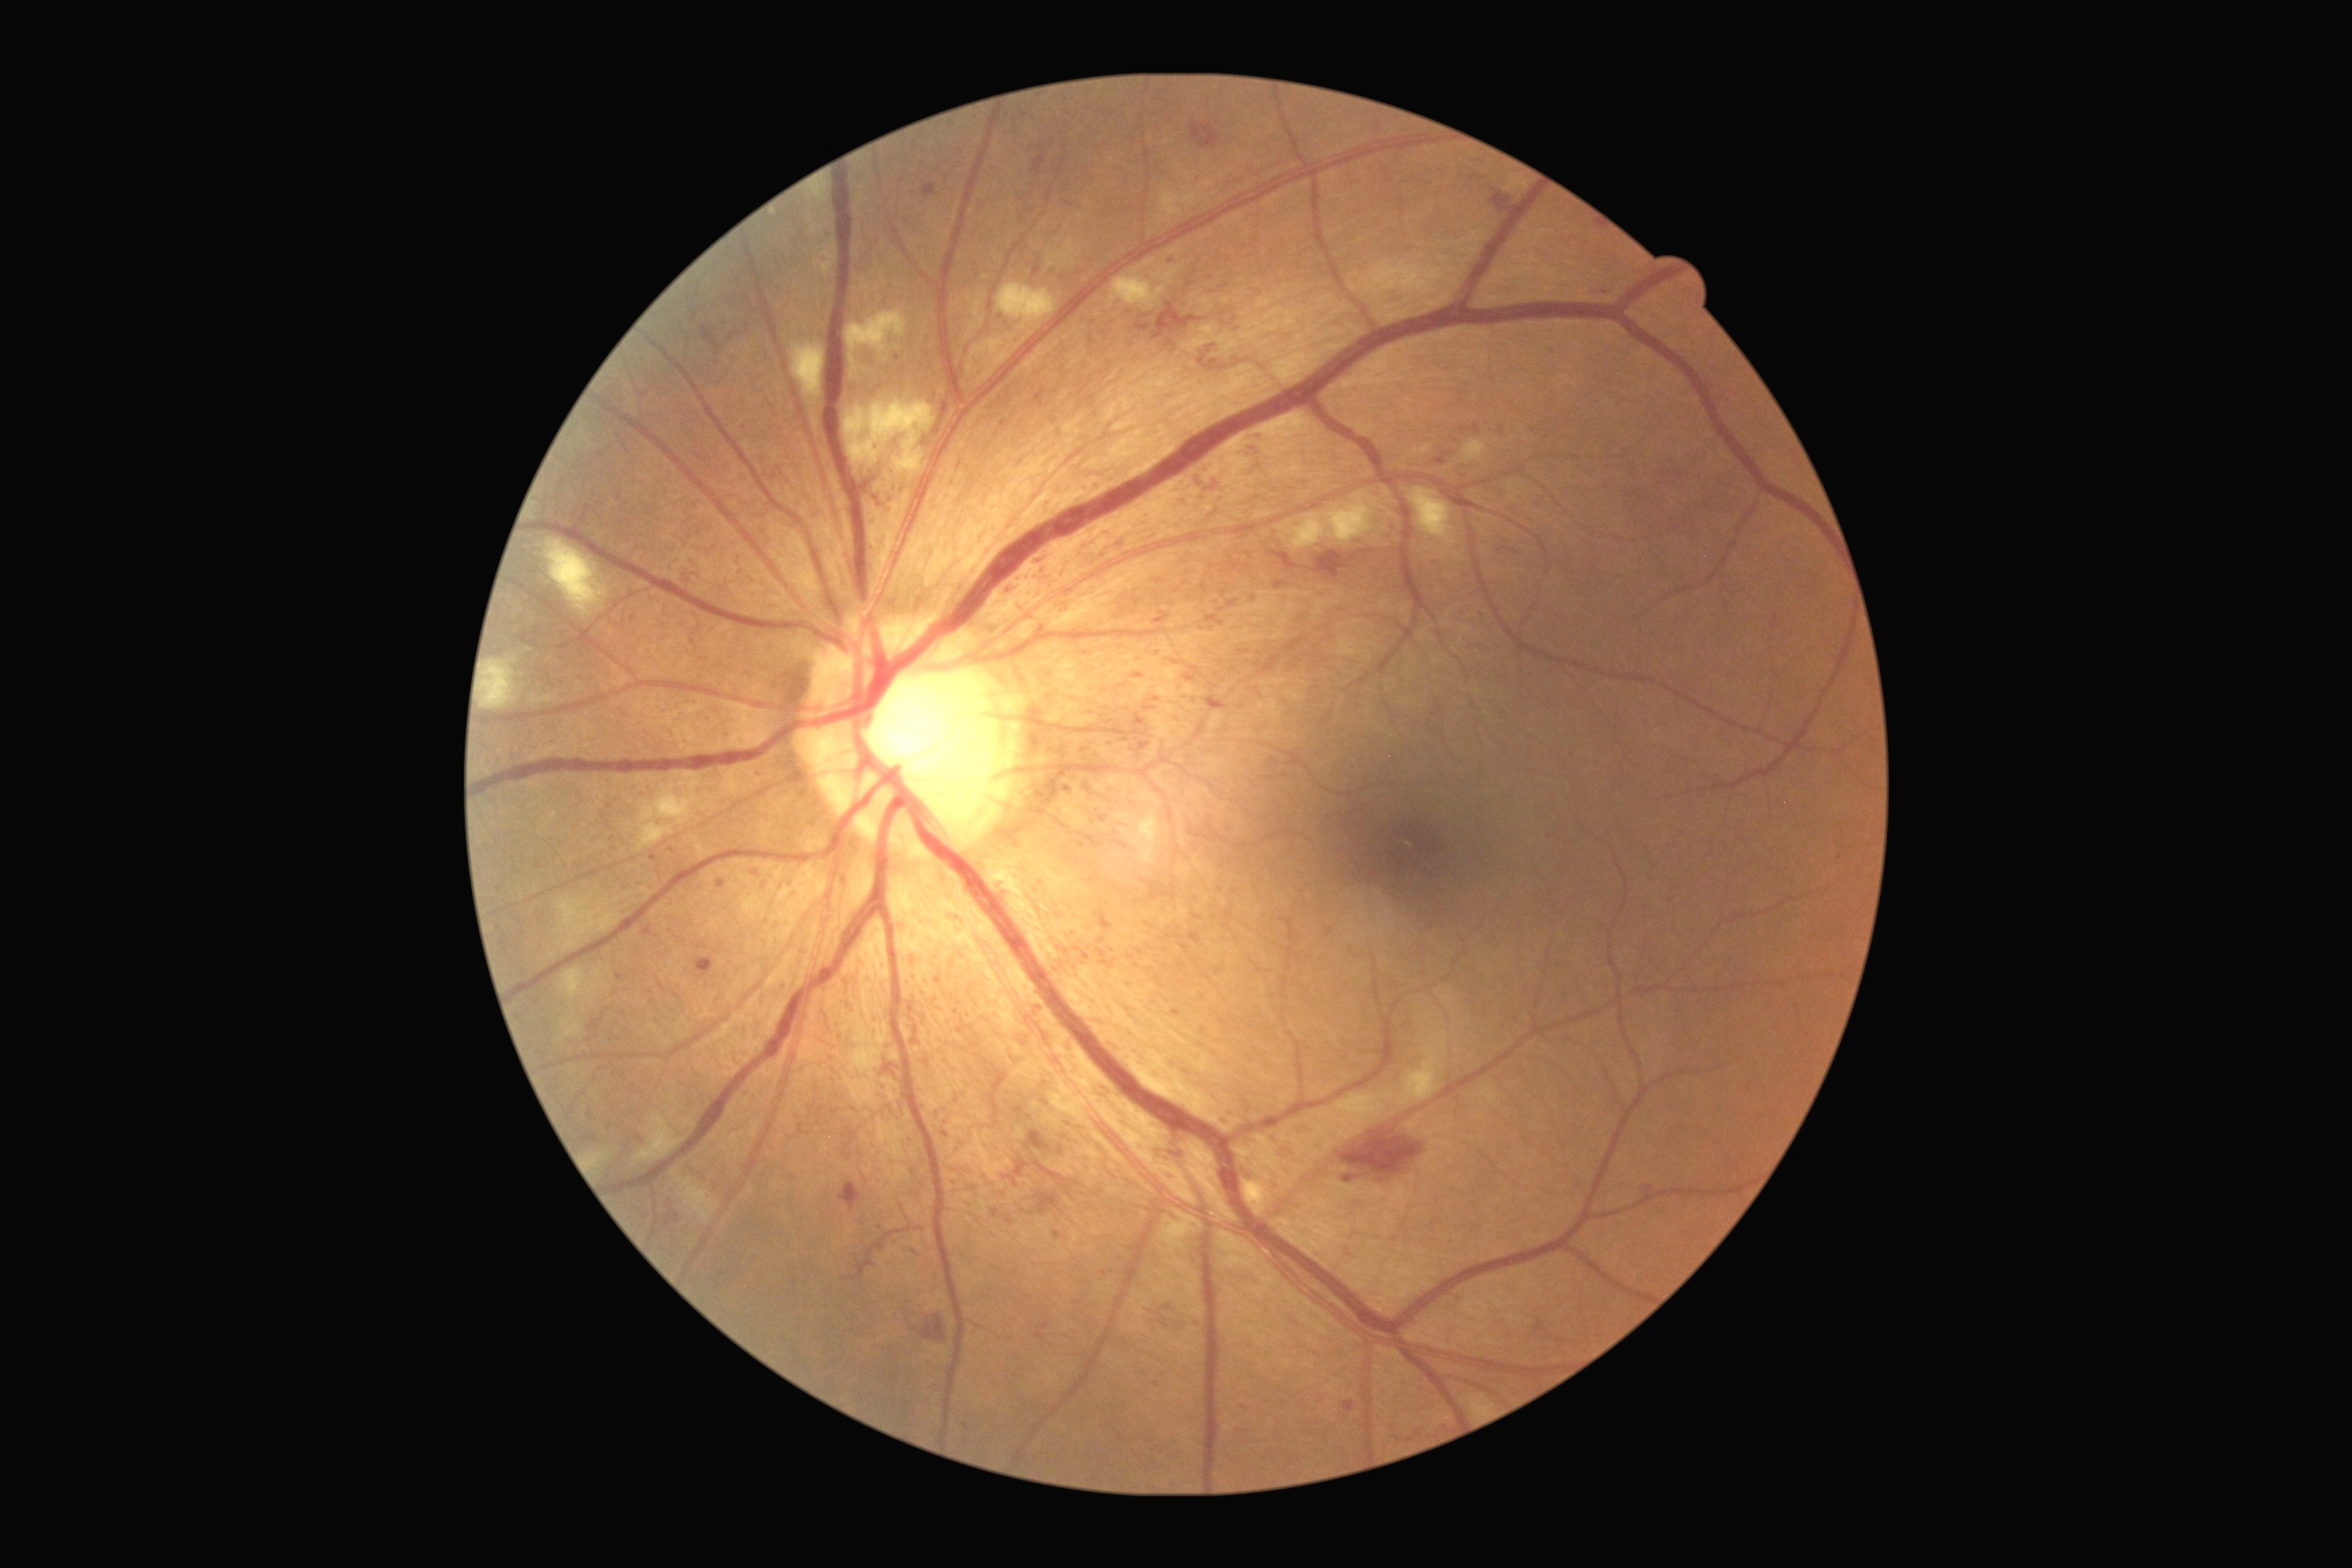

Diabetic retinopathy grade is 3
Selected lesions:
microaneurysms (partial) = bbox=[1498, 547, 1518, 556]; bbox=[1097, 912, 1113, 932]; bbox=[1643, 1186, 1654, 1195]; bbox=[1255, 431, 1262, 442]; bbox=[1073, 1300, 1083, 1304]; bbox=[798, 1124, 805, 1135]; bbox=[1066, 785, 1072, 794]; bbox=[754, 770, 765, 781]; bbox=[910, 1006, 914, 1014]; bbox=[1099, 816, 1108, 823]
Microaneurysms (small, approximate centers) near 1099/486; 826/259; 1111/950; 1048/504; 621/977; 1448/454; 1138/603; 1253/600
hemorrhages (partial) = bbox=[1032, 148, 1048, 175]; bbox=[1153, 304, 1202, 340]; bbox=[1242, 1166, 1257, 1182]; bbox=[1199, 475, 1208, 487]; bbox=[1534, 1318, 1549, 1340]; bbox=[1035, 387, 1046, 407]; bbox=[1344, 1400, 1355, 1413]; bbox=[1190, 124, 1222, 150]; bbox=[1037, 1191, 1059, 1215]; bbox=[1315, 551, 1349, 569]; bbox=[1164, 1168, 1173, 1179]; bbox=[696, 957, 714, 979]; bbox=[1222, 1117, 1231, 1124]
Hemorrhages (small, approximate centers) near 1203/497
soft exudates (partial) = bbox=[810, 215, 825, 237]; bbox=[1161, 190, 1200, 217]; bbox=[1110, 259, 1168, 311]; bbox=[790, 342, 825, 398]; bbox=[1409, 489, 1458, 547]; bbox=[1115, 810, 1162, 867]; bbox=[1279, 493, 1380, 549]; bbox=[558, 896, 622, 954]; bbox=[484, 660, 518, 710]; bbox=[814, 240, 838, 279]; bbox=[547, 540, 609, 618]
Soft exudates (small, approximate centers) near 674/1175